Acquired with a NIDEK AFC-230: 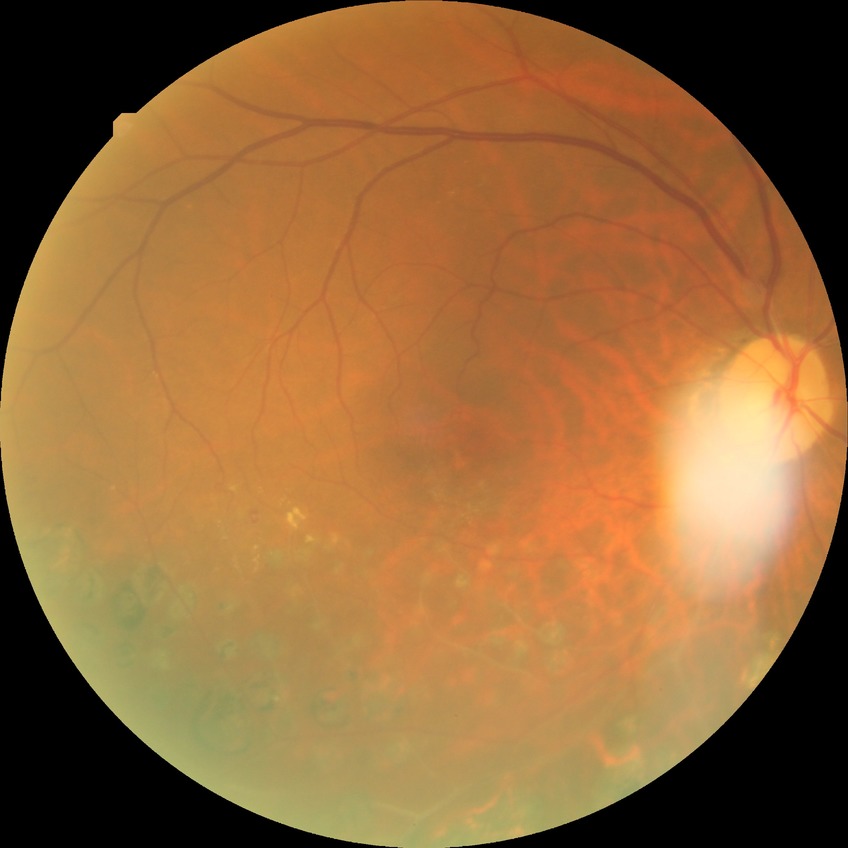
{"davis_grade": "NDR"}